60° FOV; image size 2212x1659; fundus photo taken with a portable handheld camera: 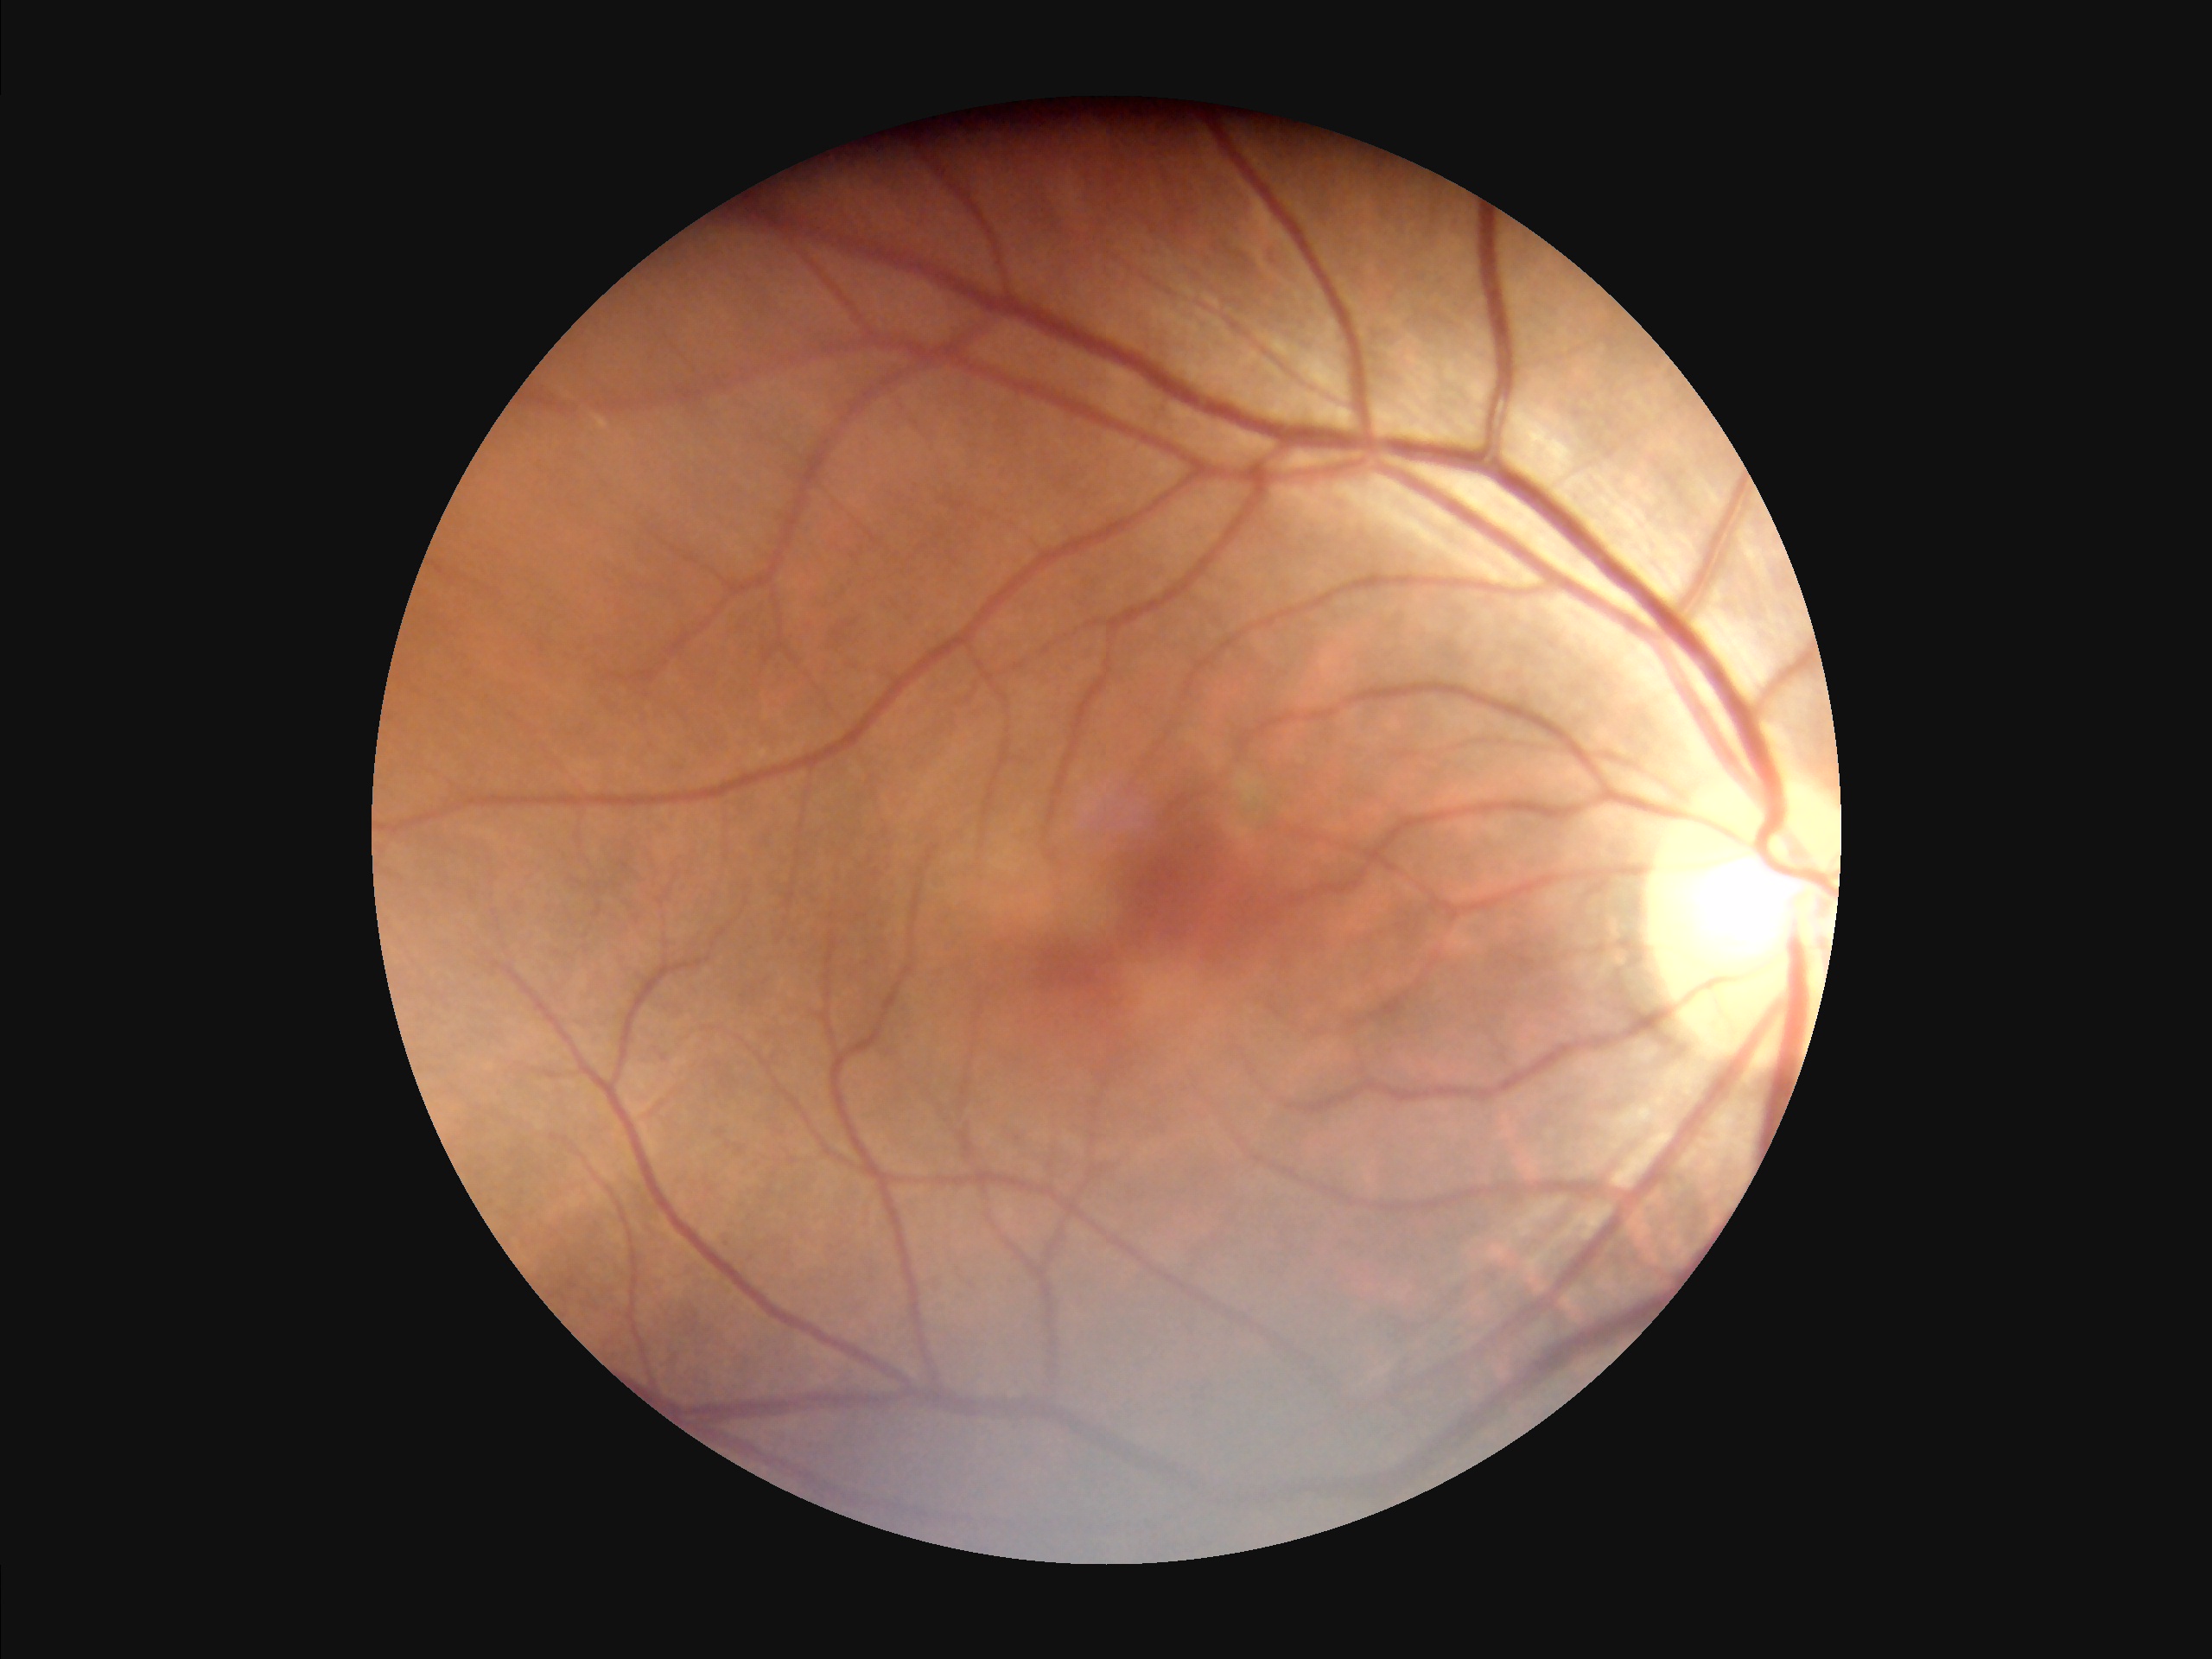

Quality assessment: clarity: poor | contrast: adequate | overall: acceptable | illumination/color: satisfactory.